Clarity RetCam 3, 130° FOV. Pediatric wide-field fundus photograph
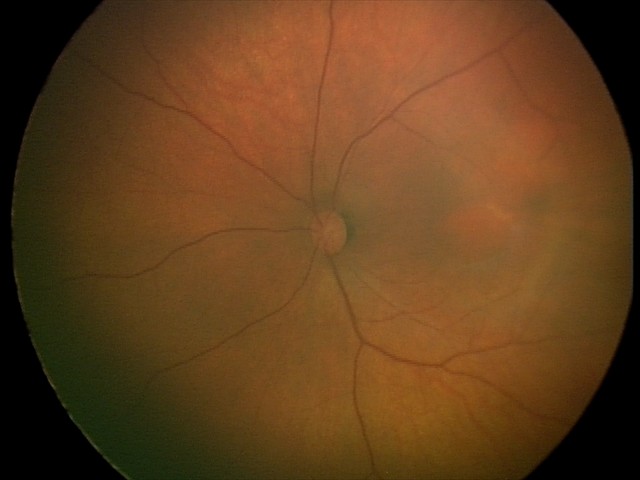 Diagnosis: normal retinal appearance.